45-degree field of view:
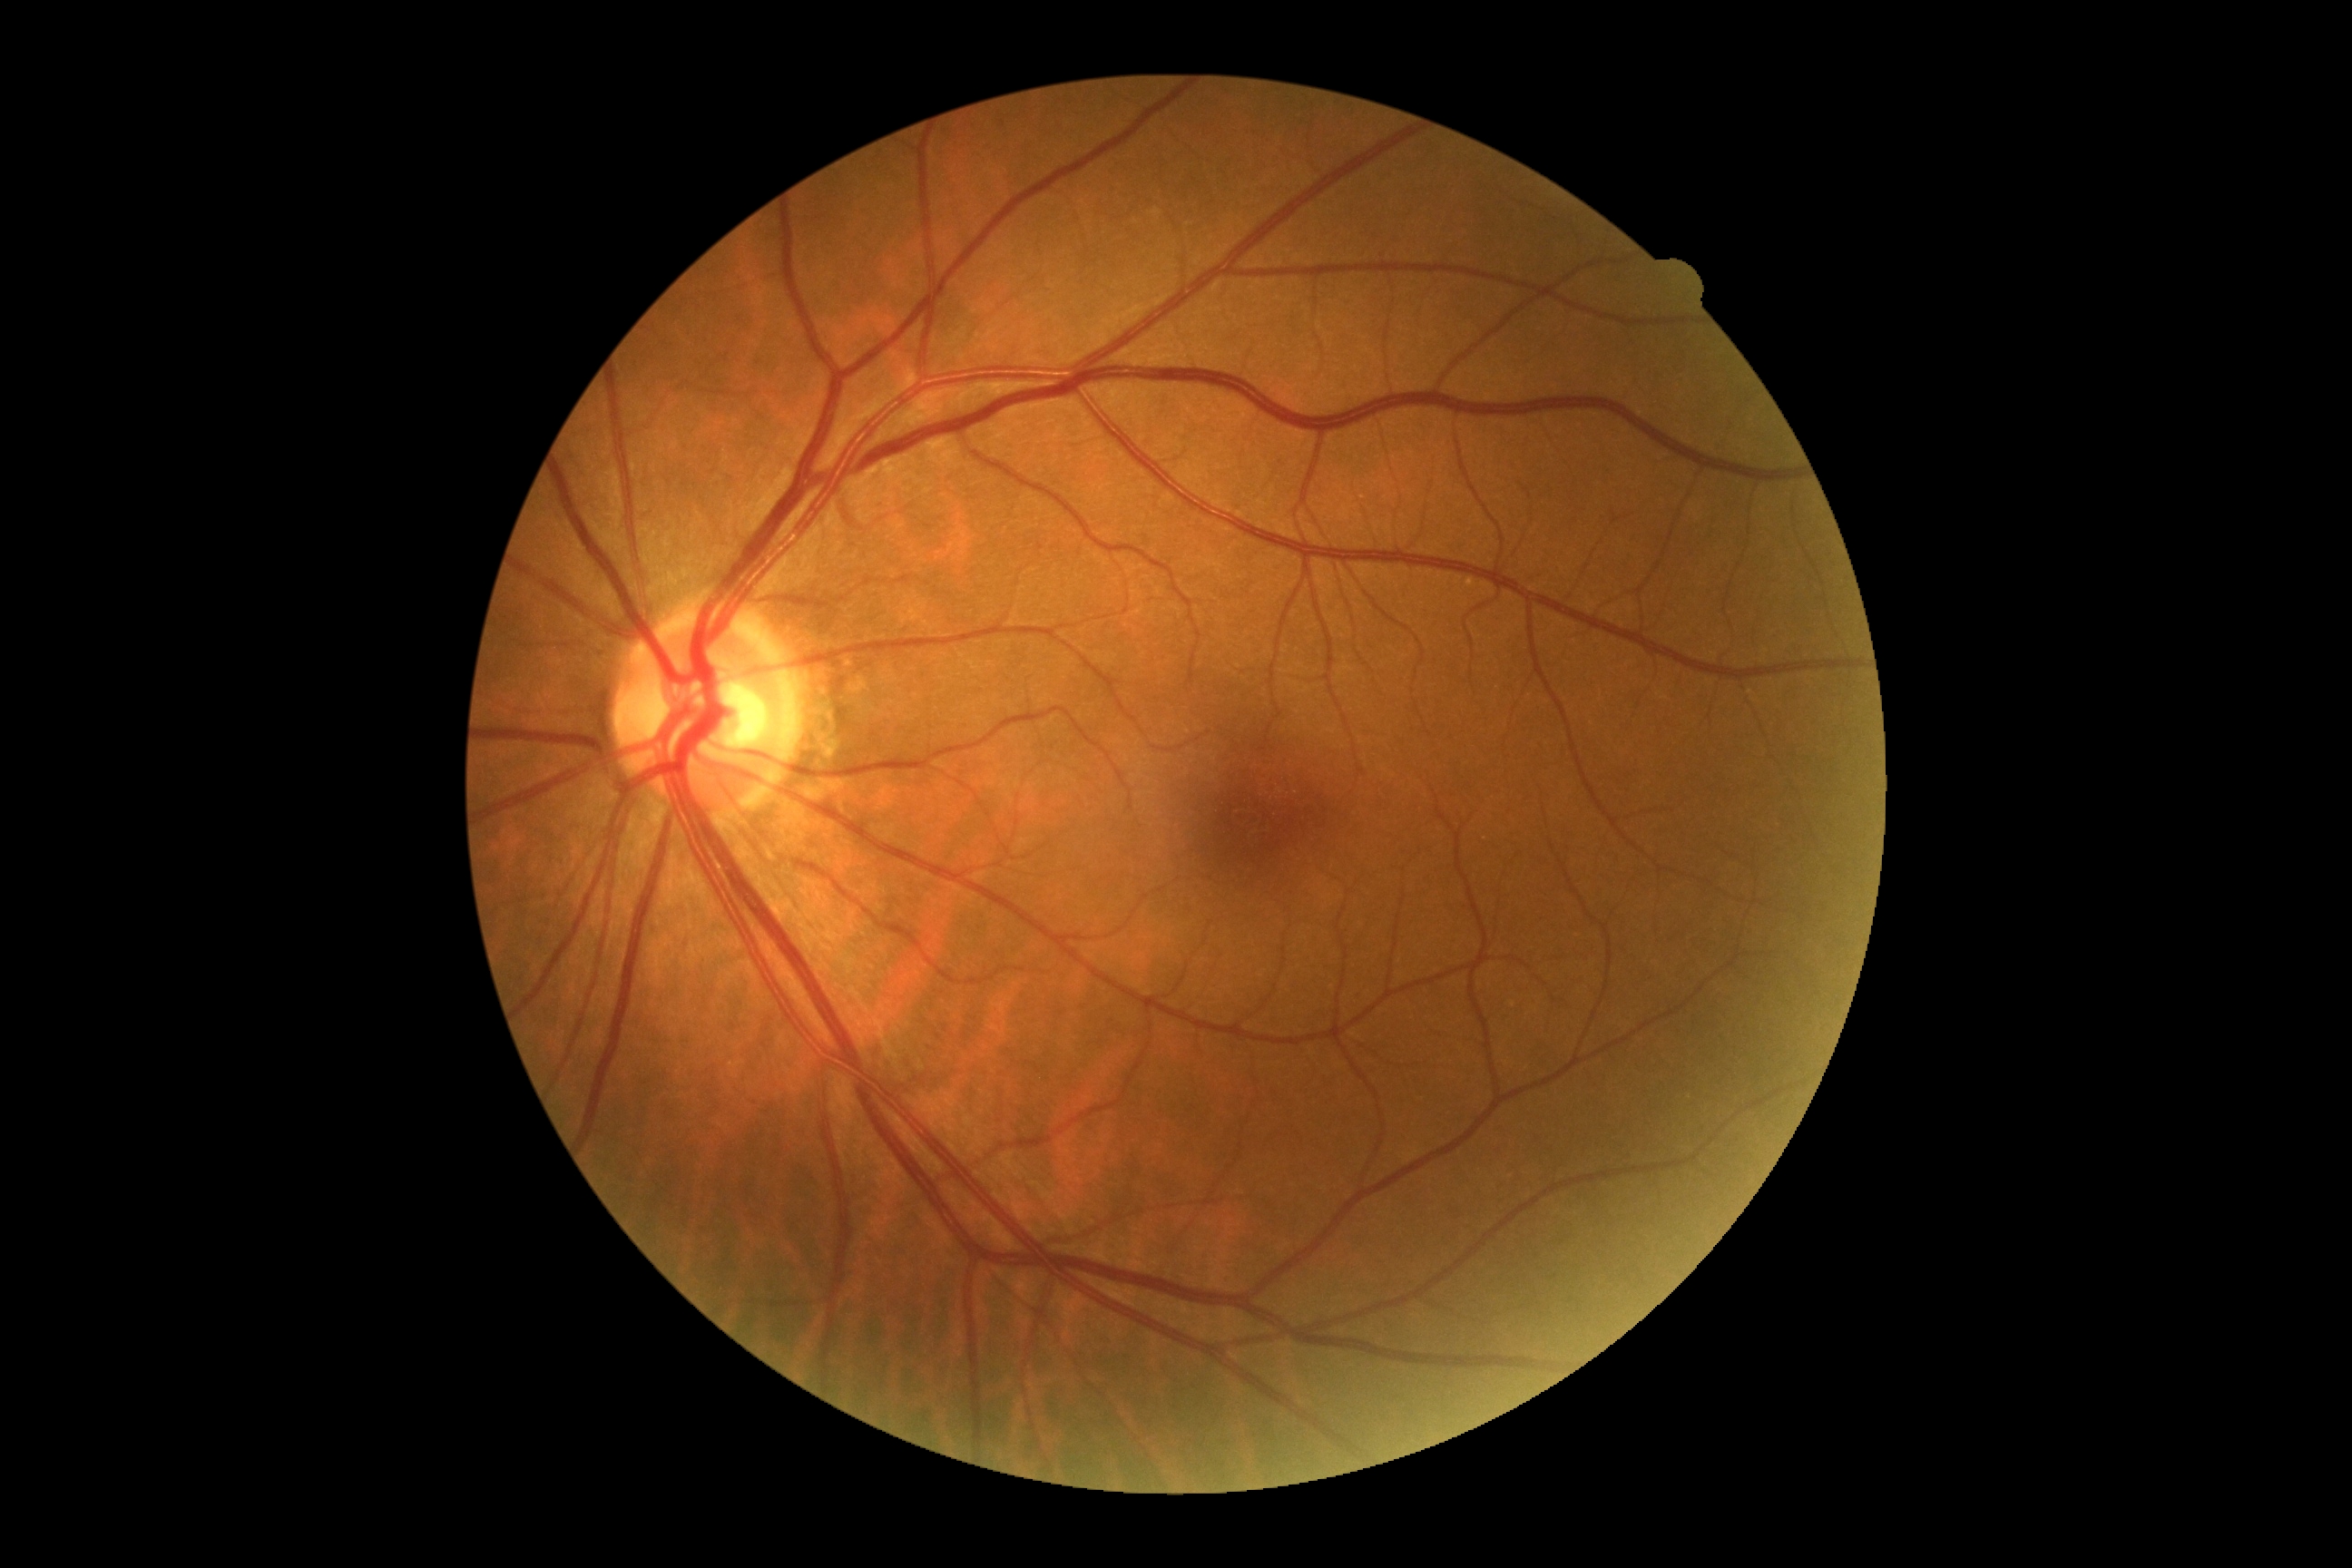

Diabetic retinopathy grade: no apparent retinopathy (0).